Macula-centered field — 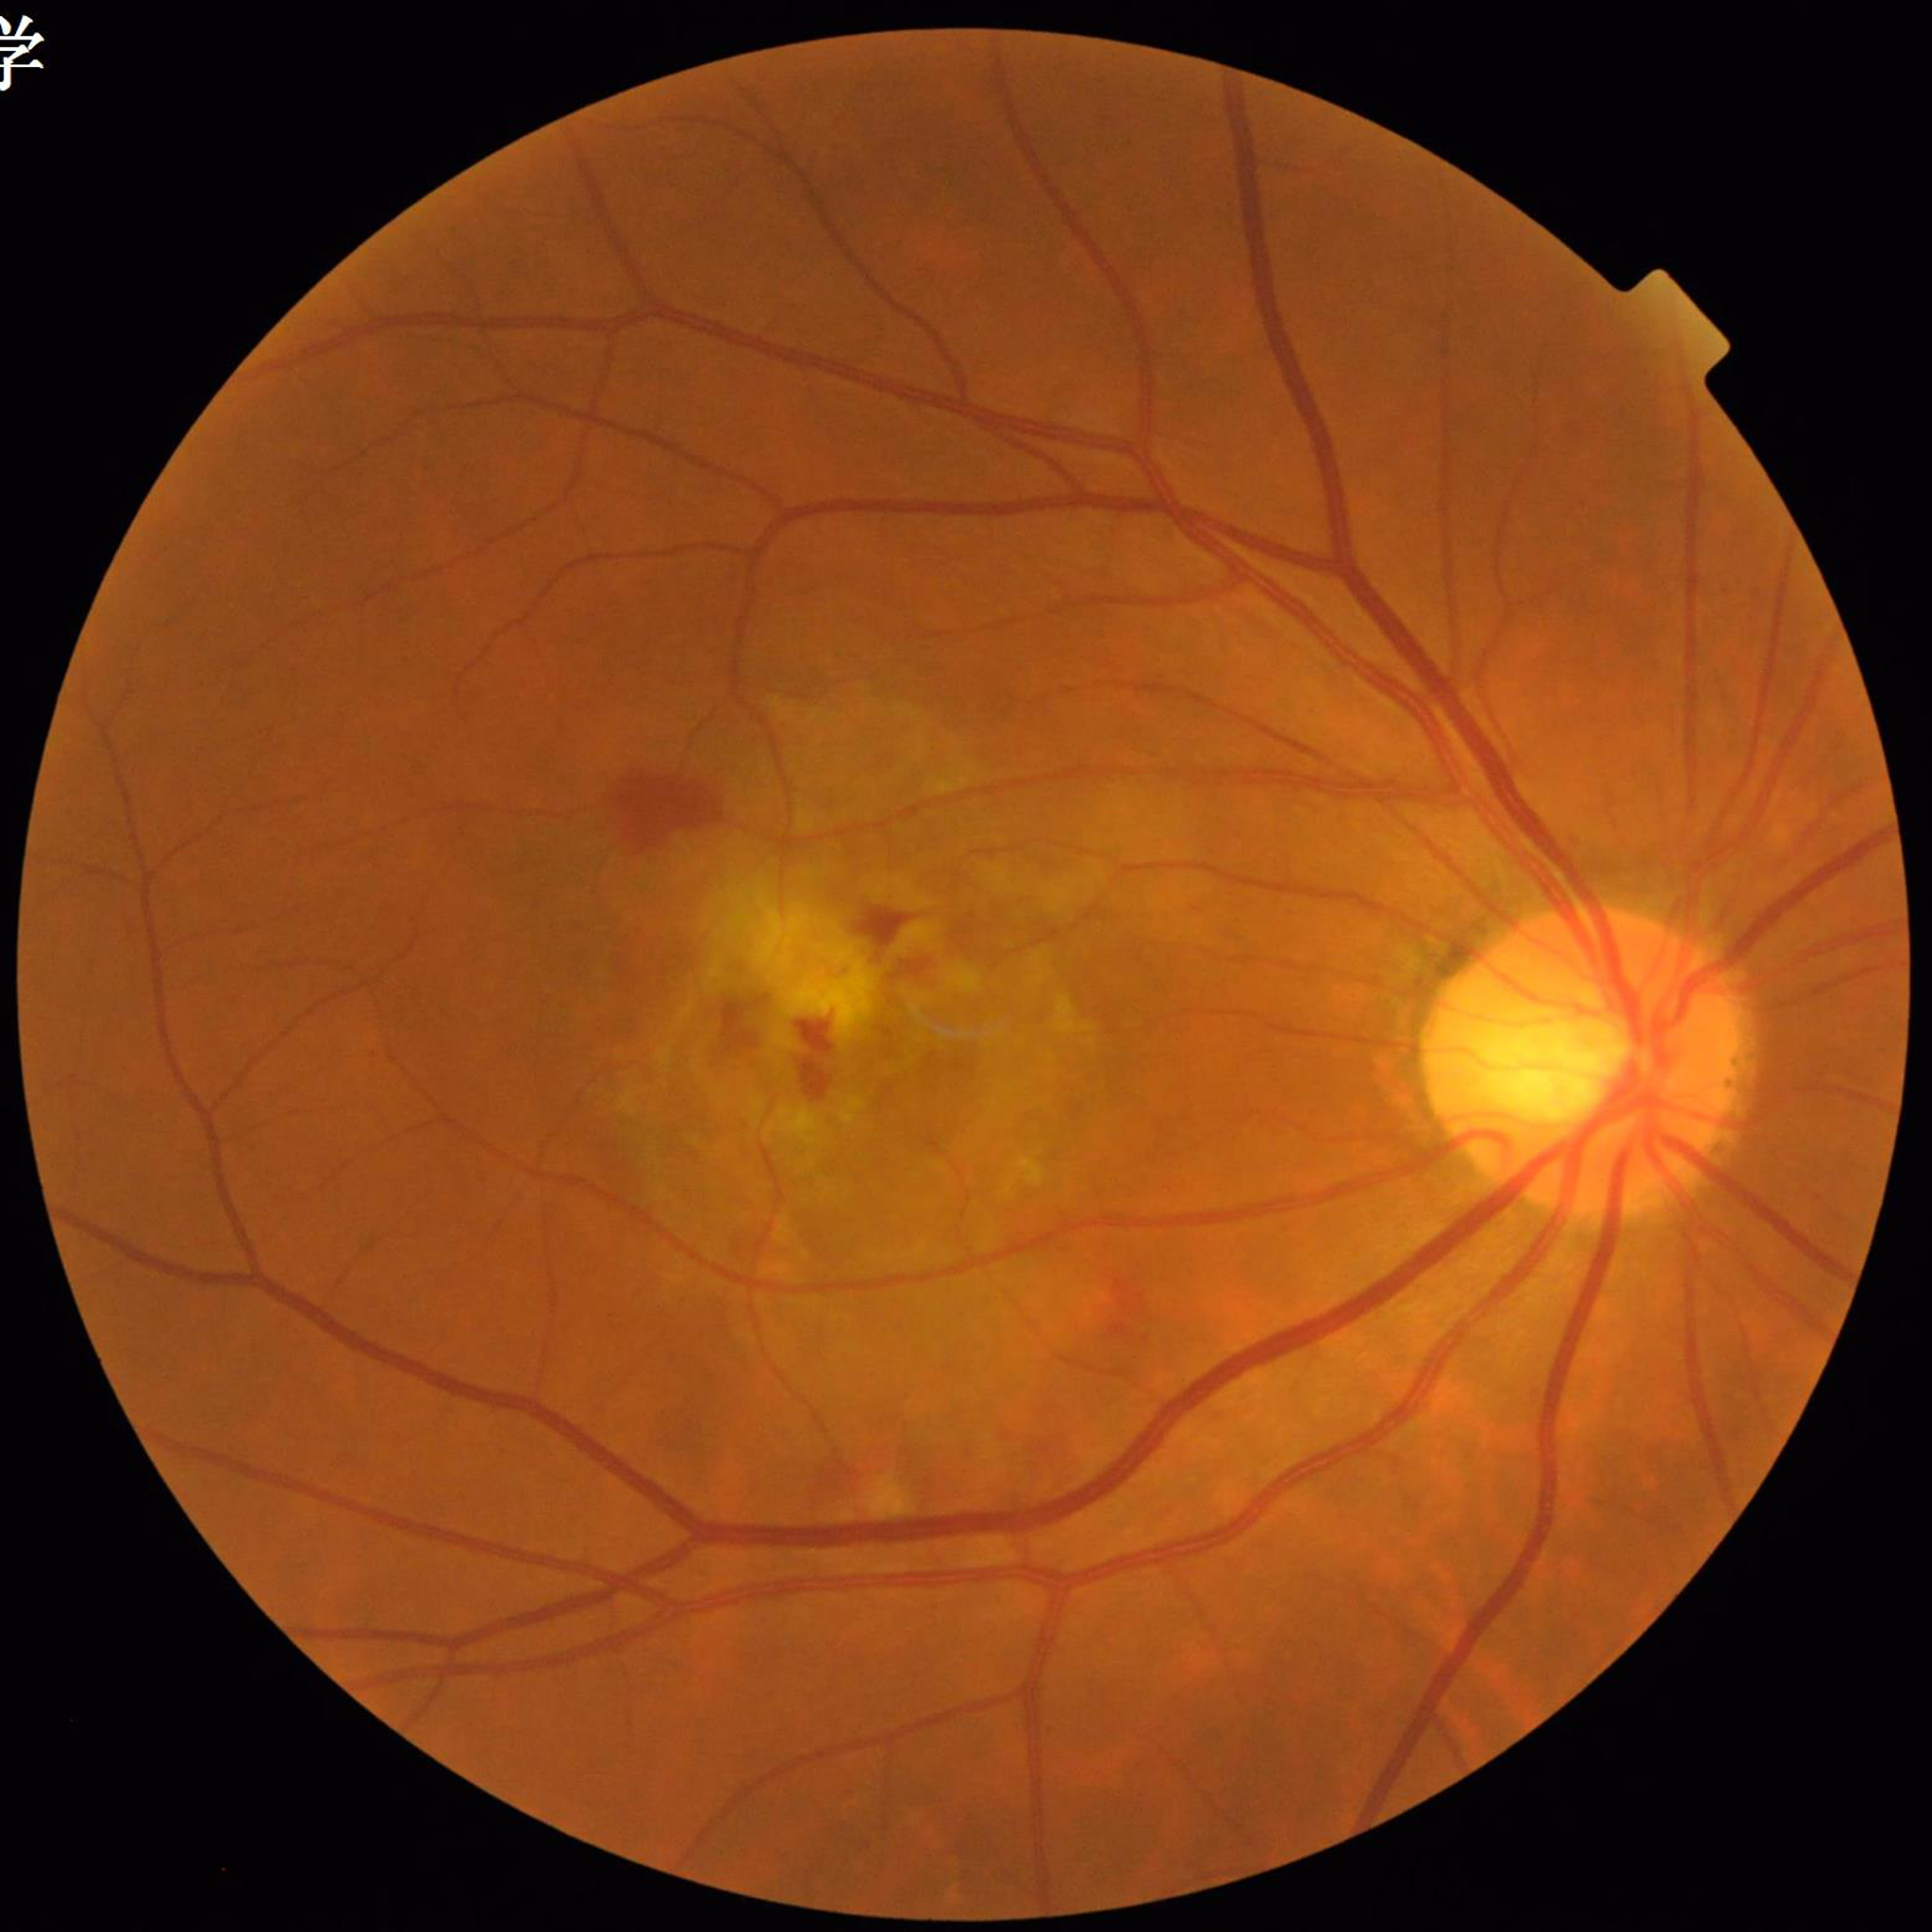

{
  "diagnosis": "age-related macular degeneration"
}